Wide-field contact fundus photograph of an infant: 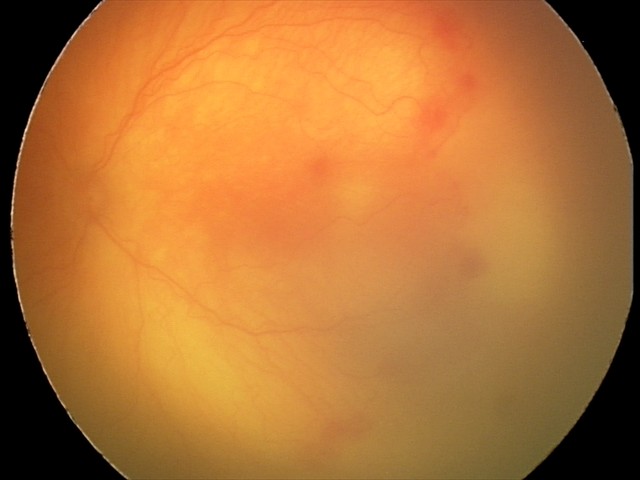
Impression: aggressive retinopathy of prematurity (A-ROP)